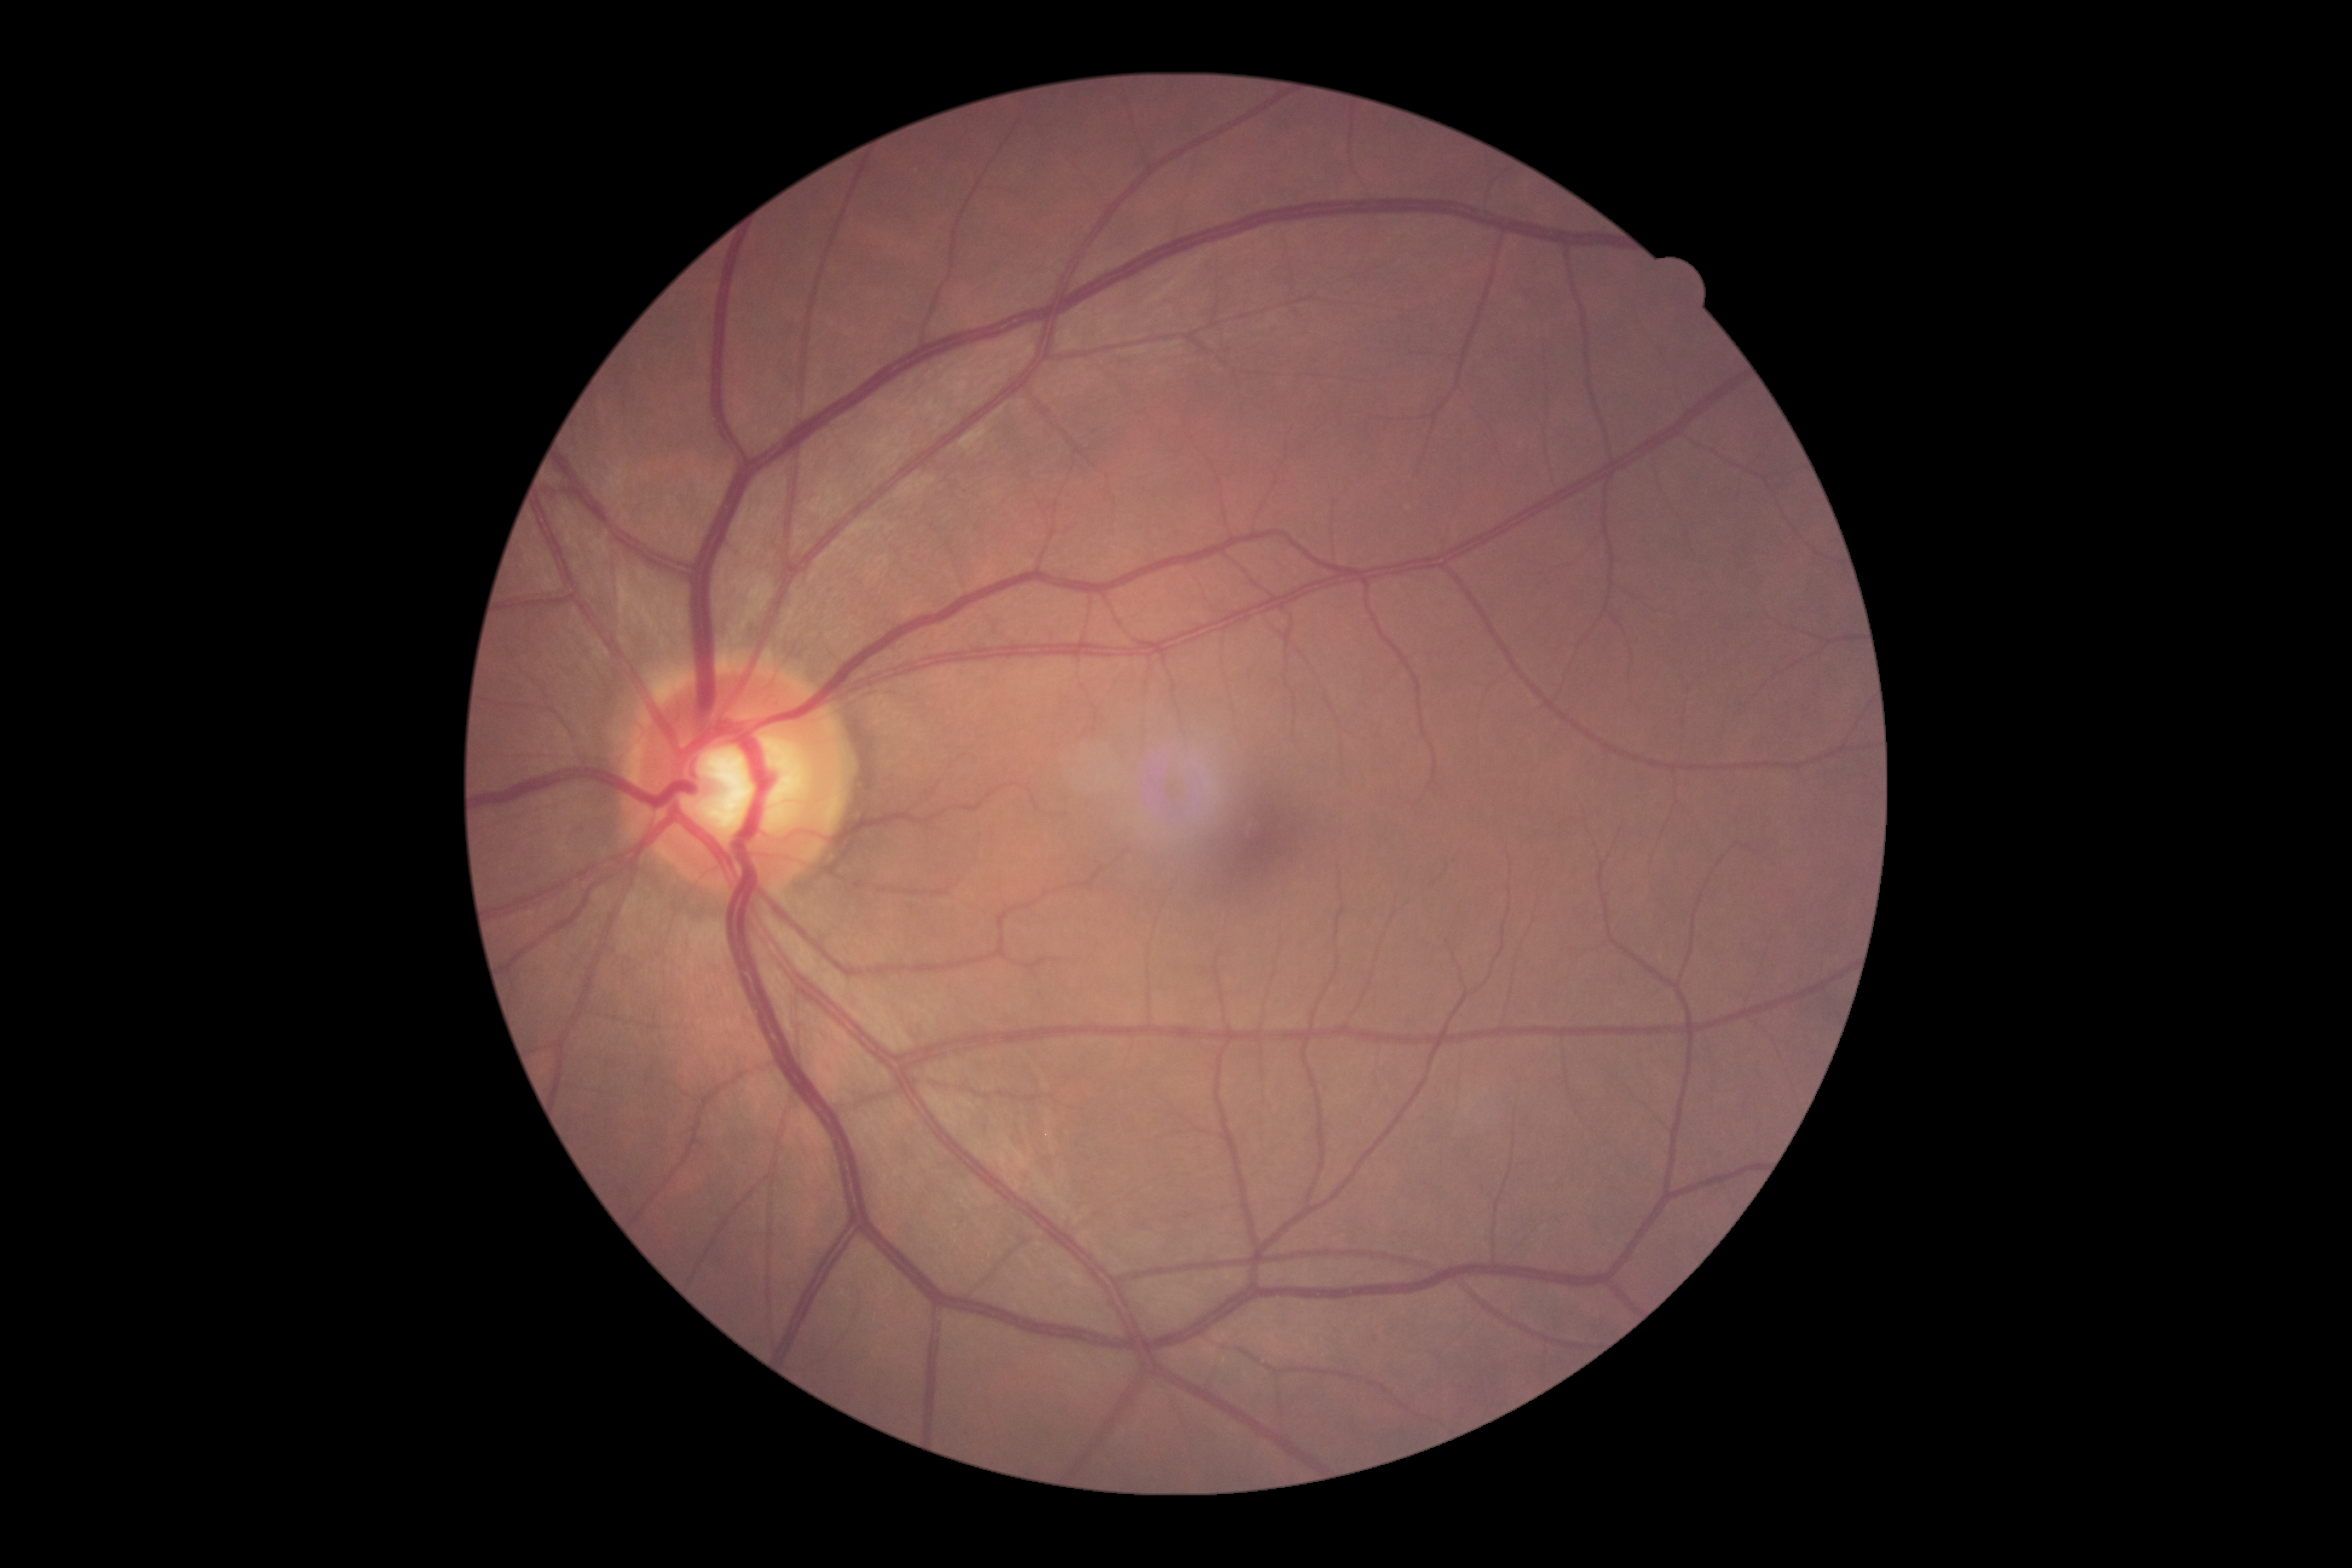
DR stage is grade 0 (no apparent retinopathy).